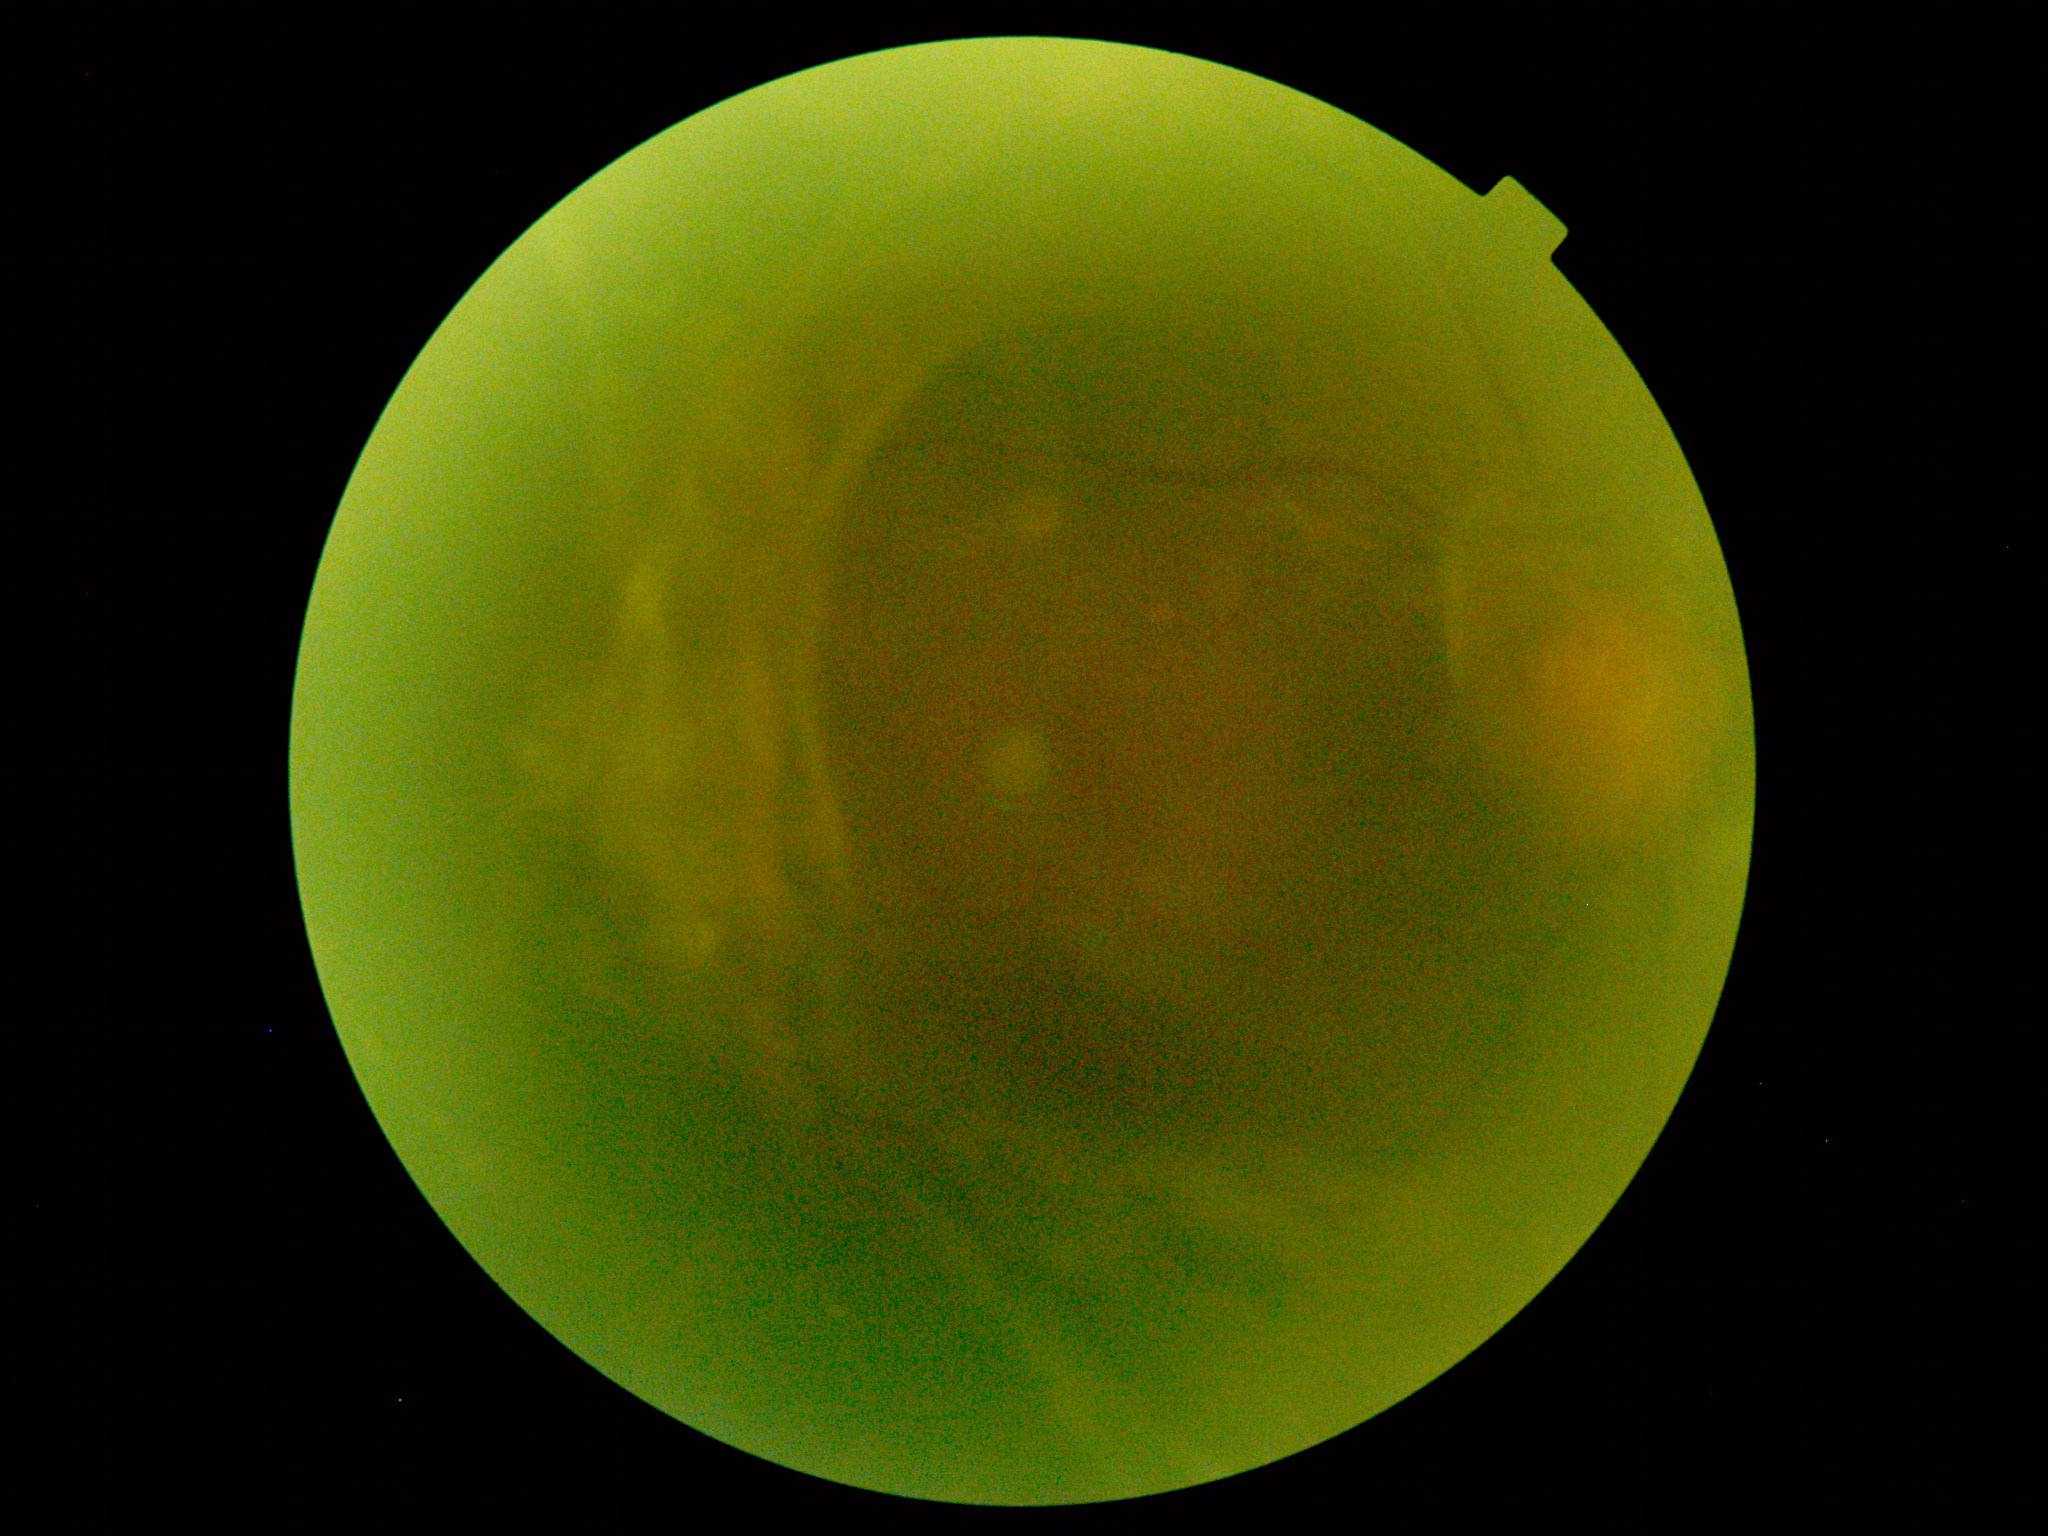
DR grade: proliferative diabetic retinopathy (4).